Color fundus photograph: 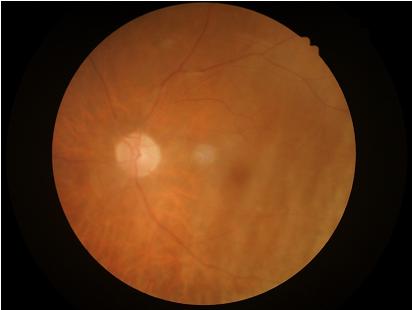

Vessels and details are readily distinguishable. Out of focus; structures are indistinct. Overall quality is poor; the image is difficult to grade. There is over- or under-exposure or a color cast.